Acquired with a Topcon TRC-NW400. 70-year-old patient. 2212x1661px. Disc-centered field:
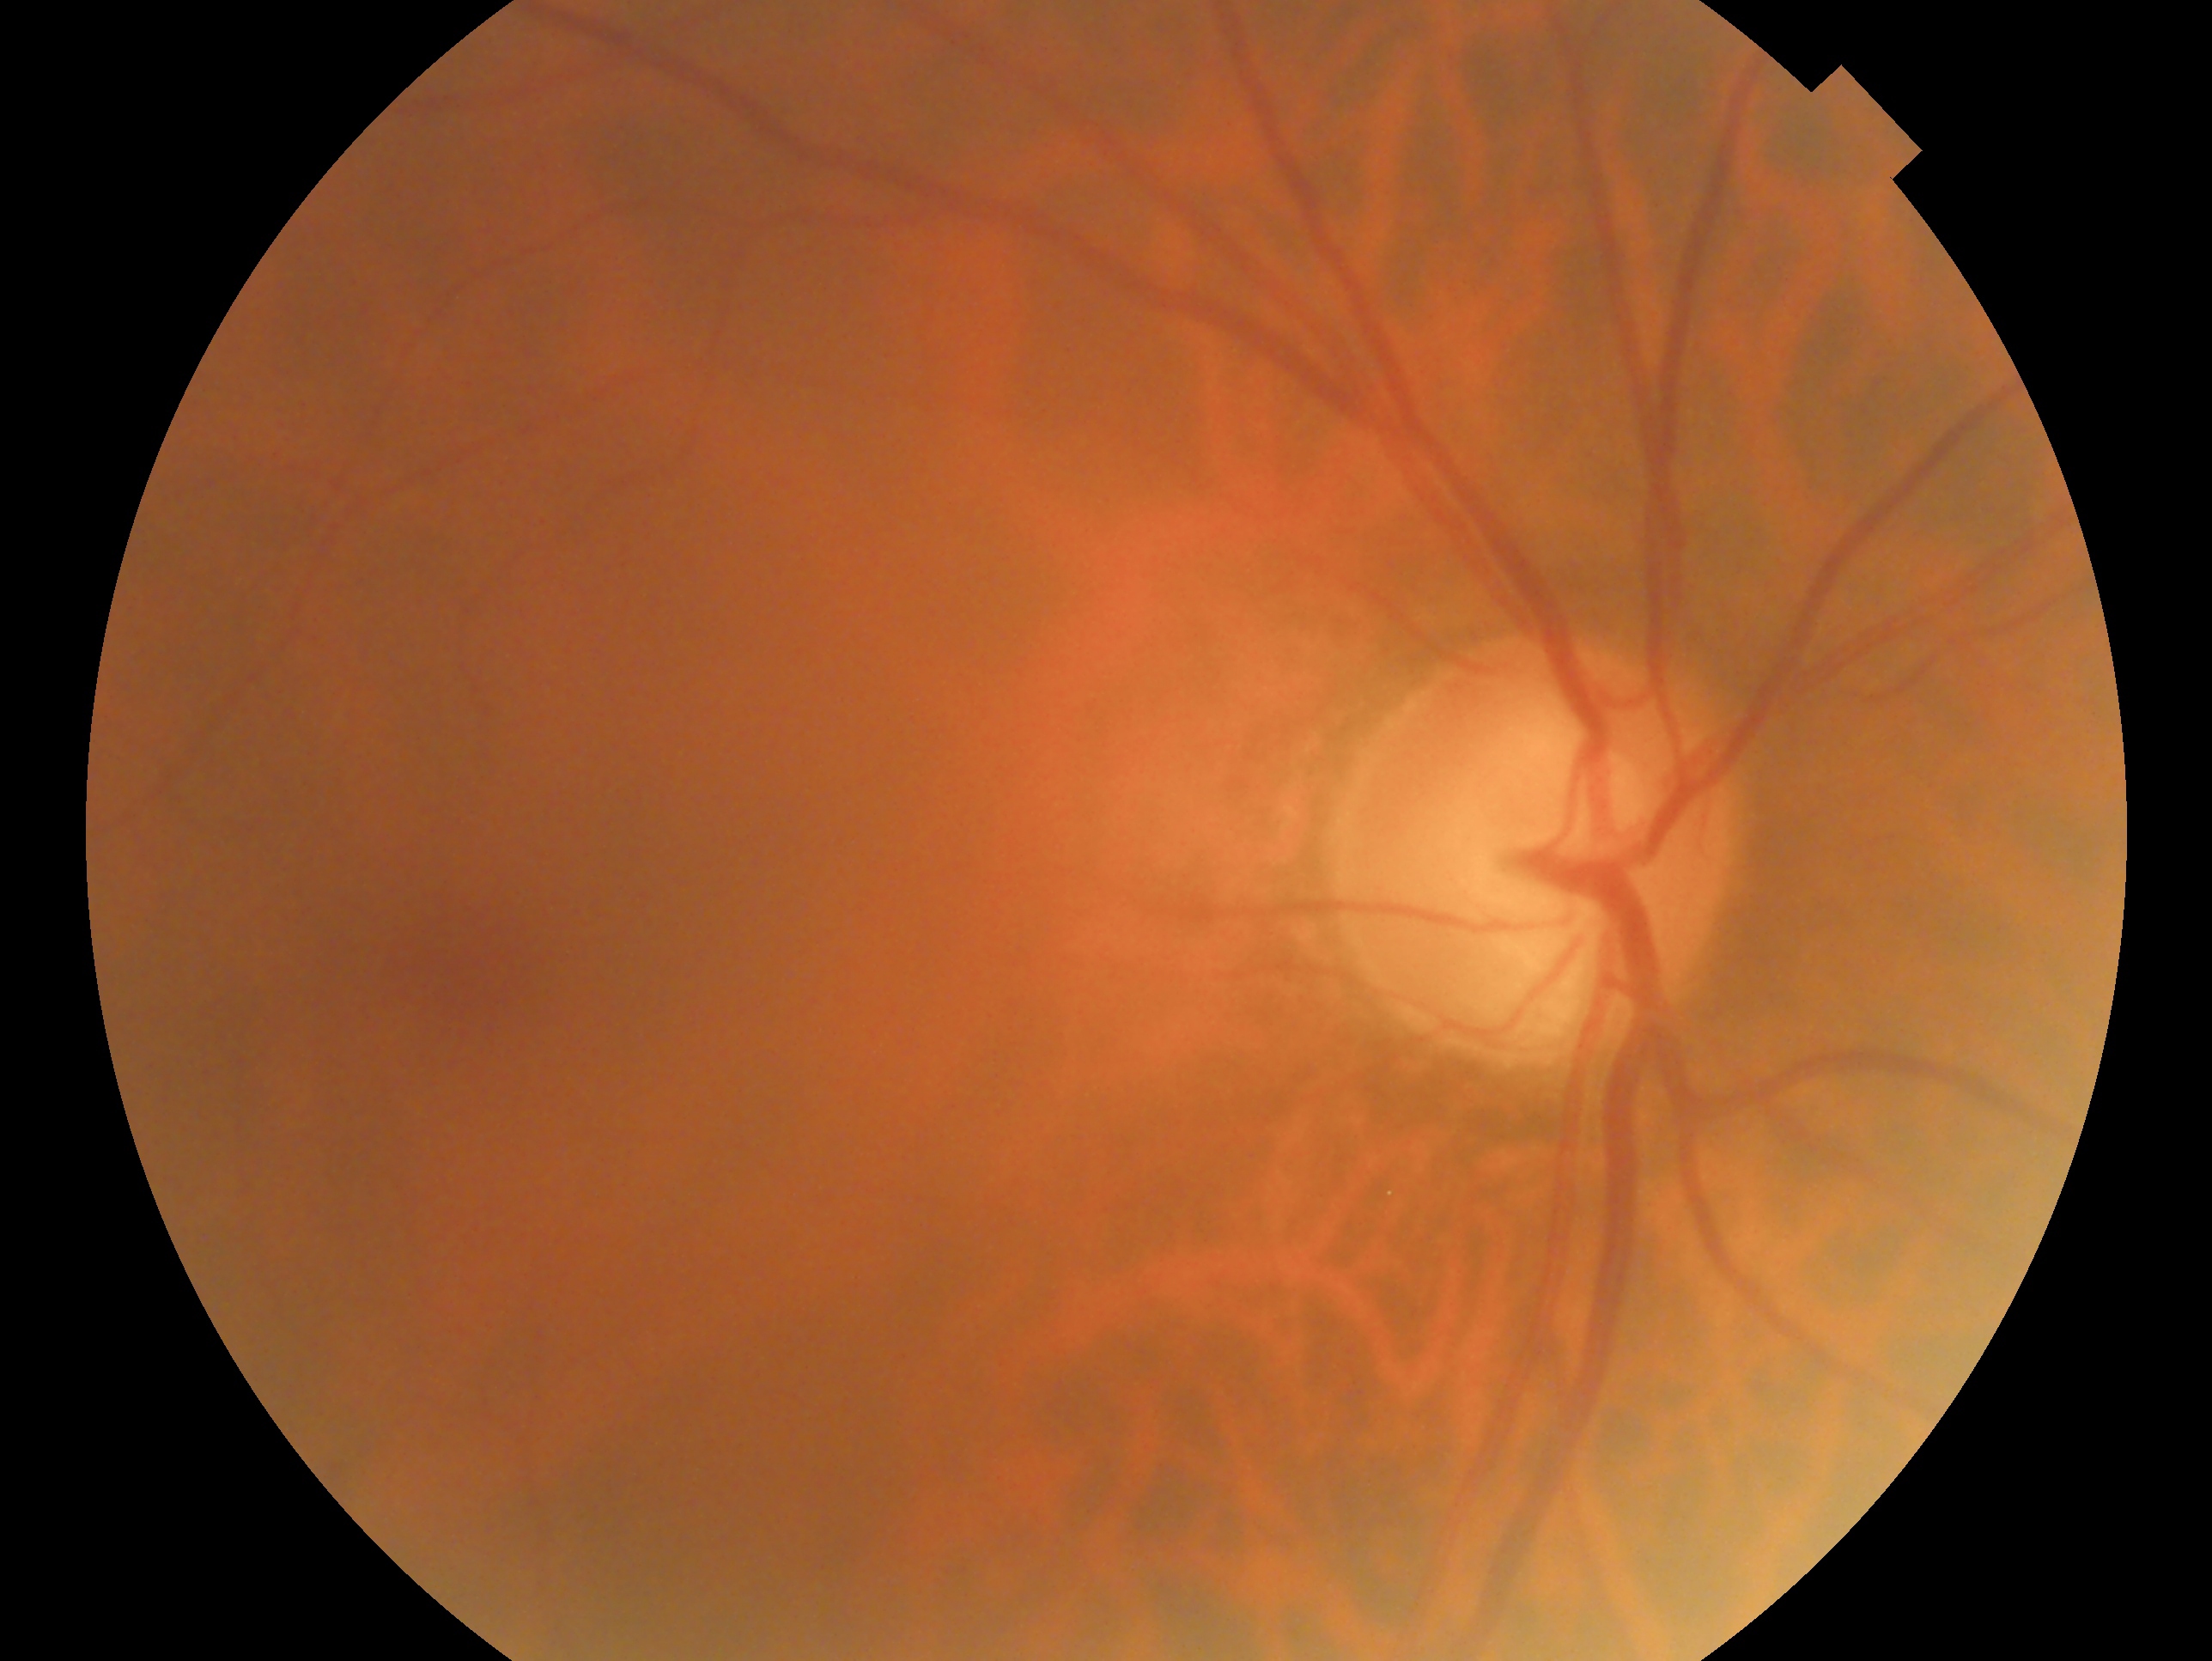
This is the right eye.
Glaucoma diagnosis — glaucomatous.